UWF retinal mosaic
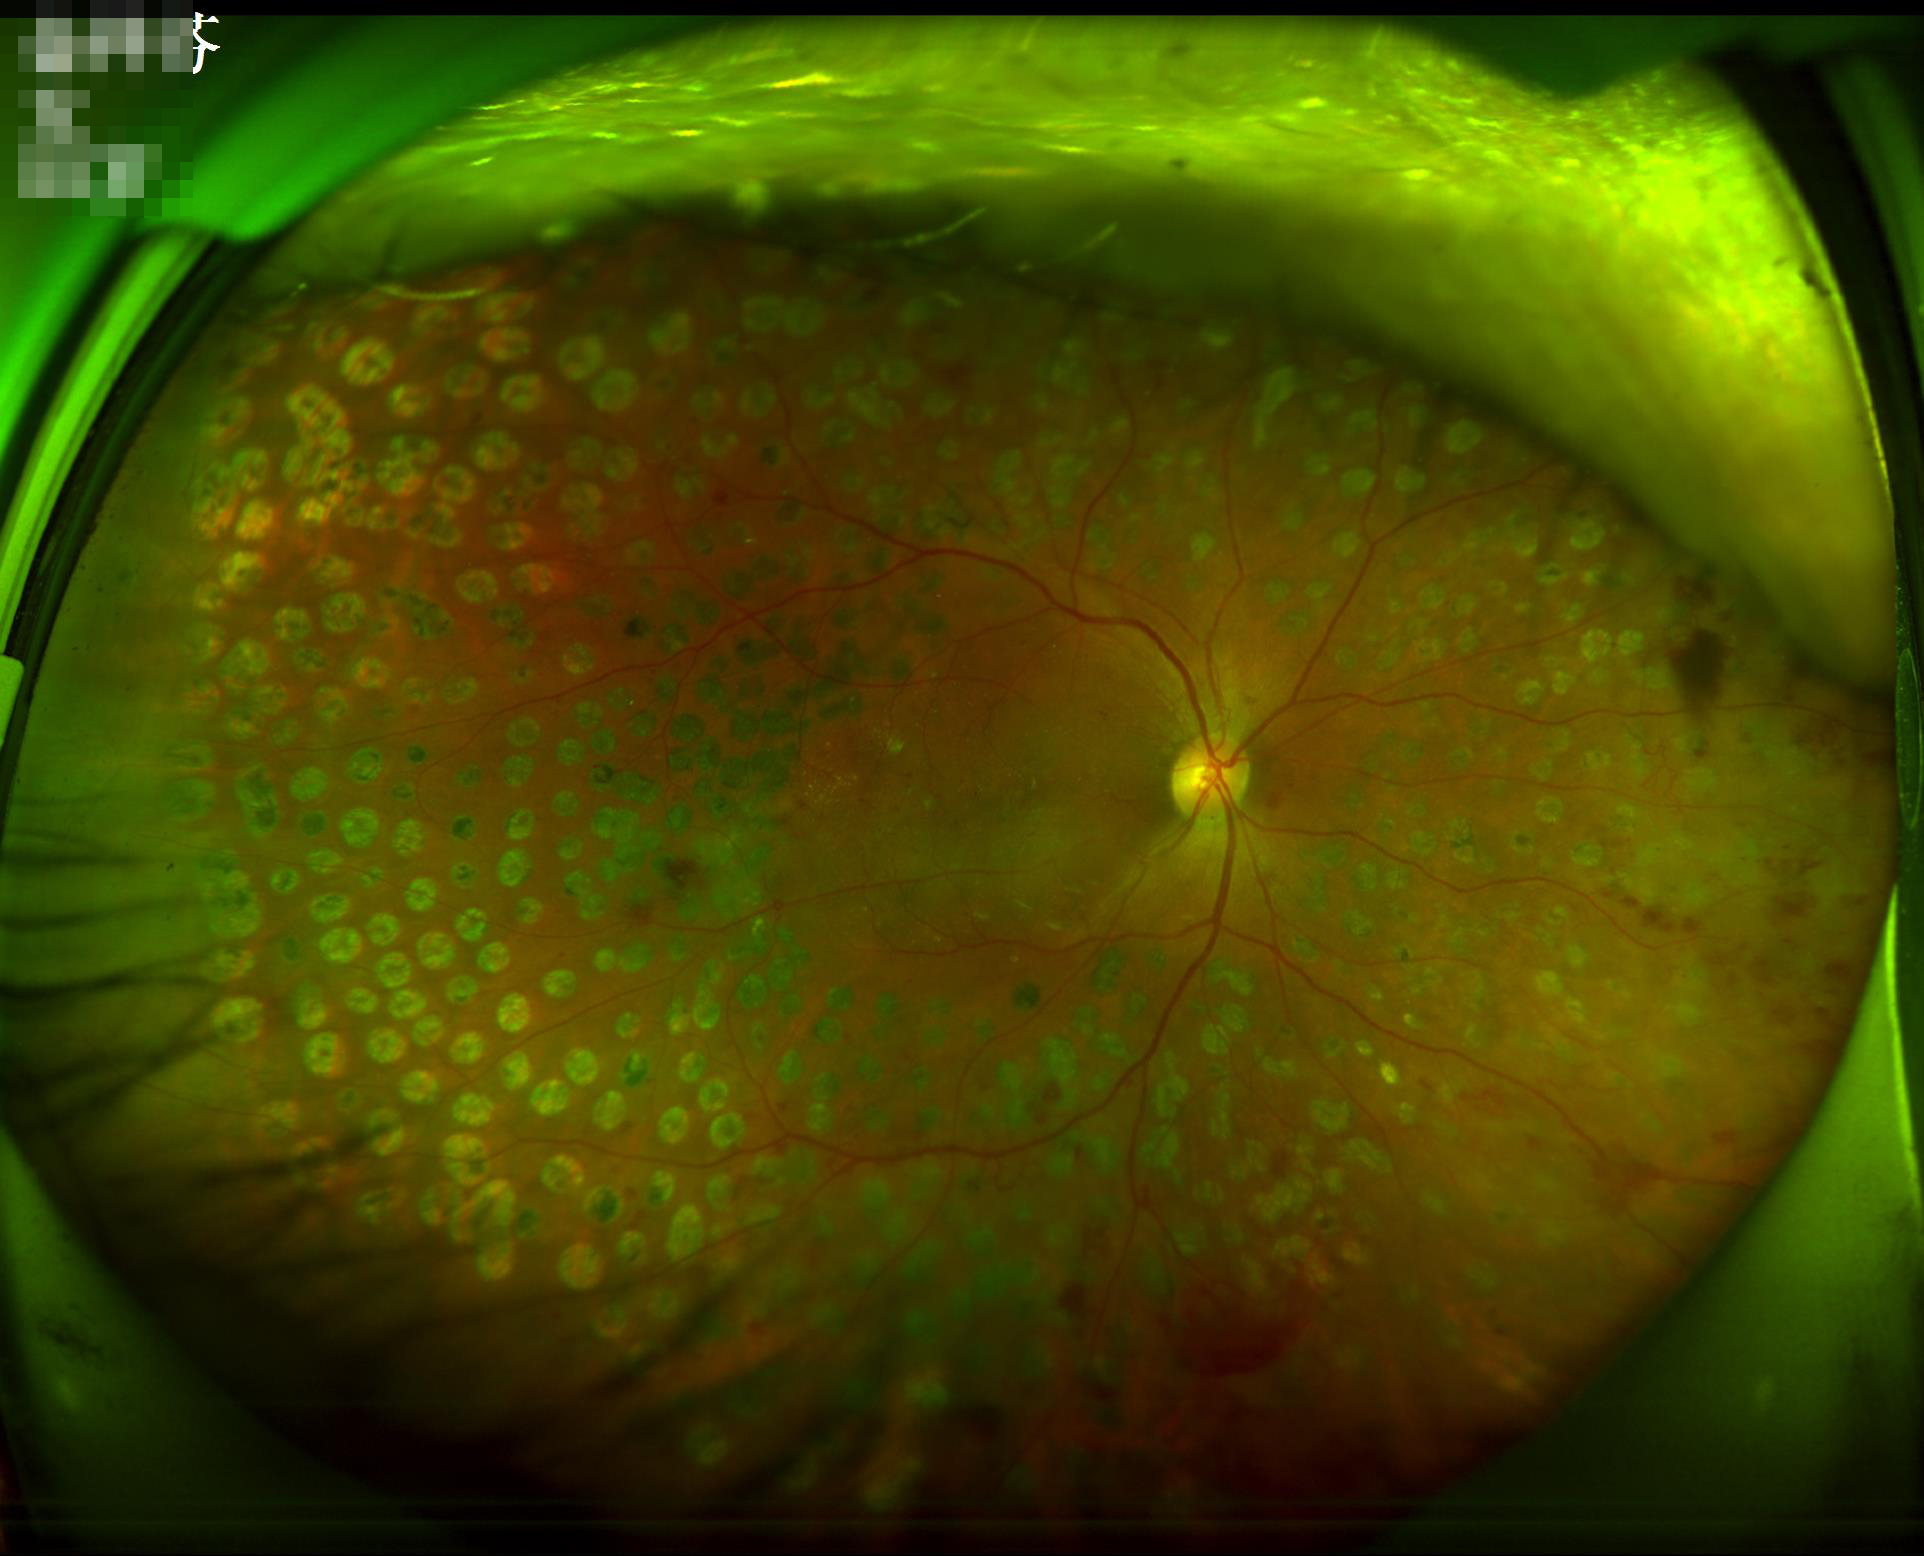
Overall quality: acceptable; Illumination: even; Contrast: adequate; Sharpness: in focus.